Posterior pole photograph; 45° FOV; without pupil dilation; 848 by 848 pixels: 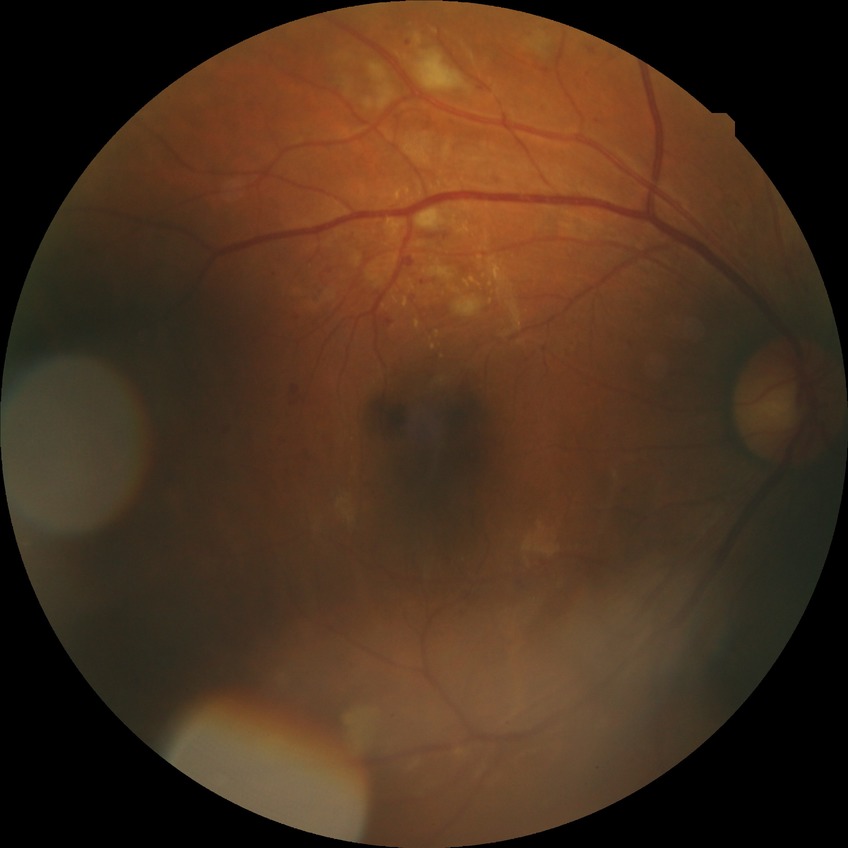

DR grade: PPDR.